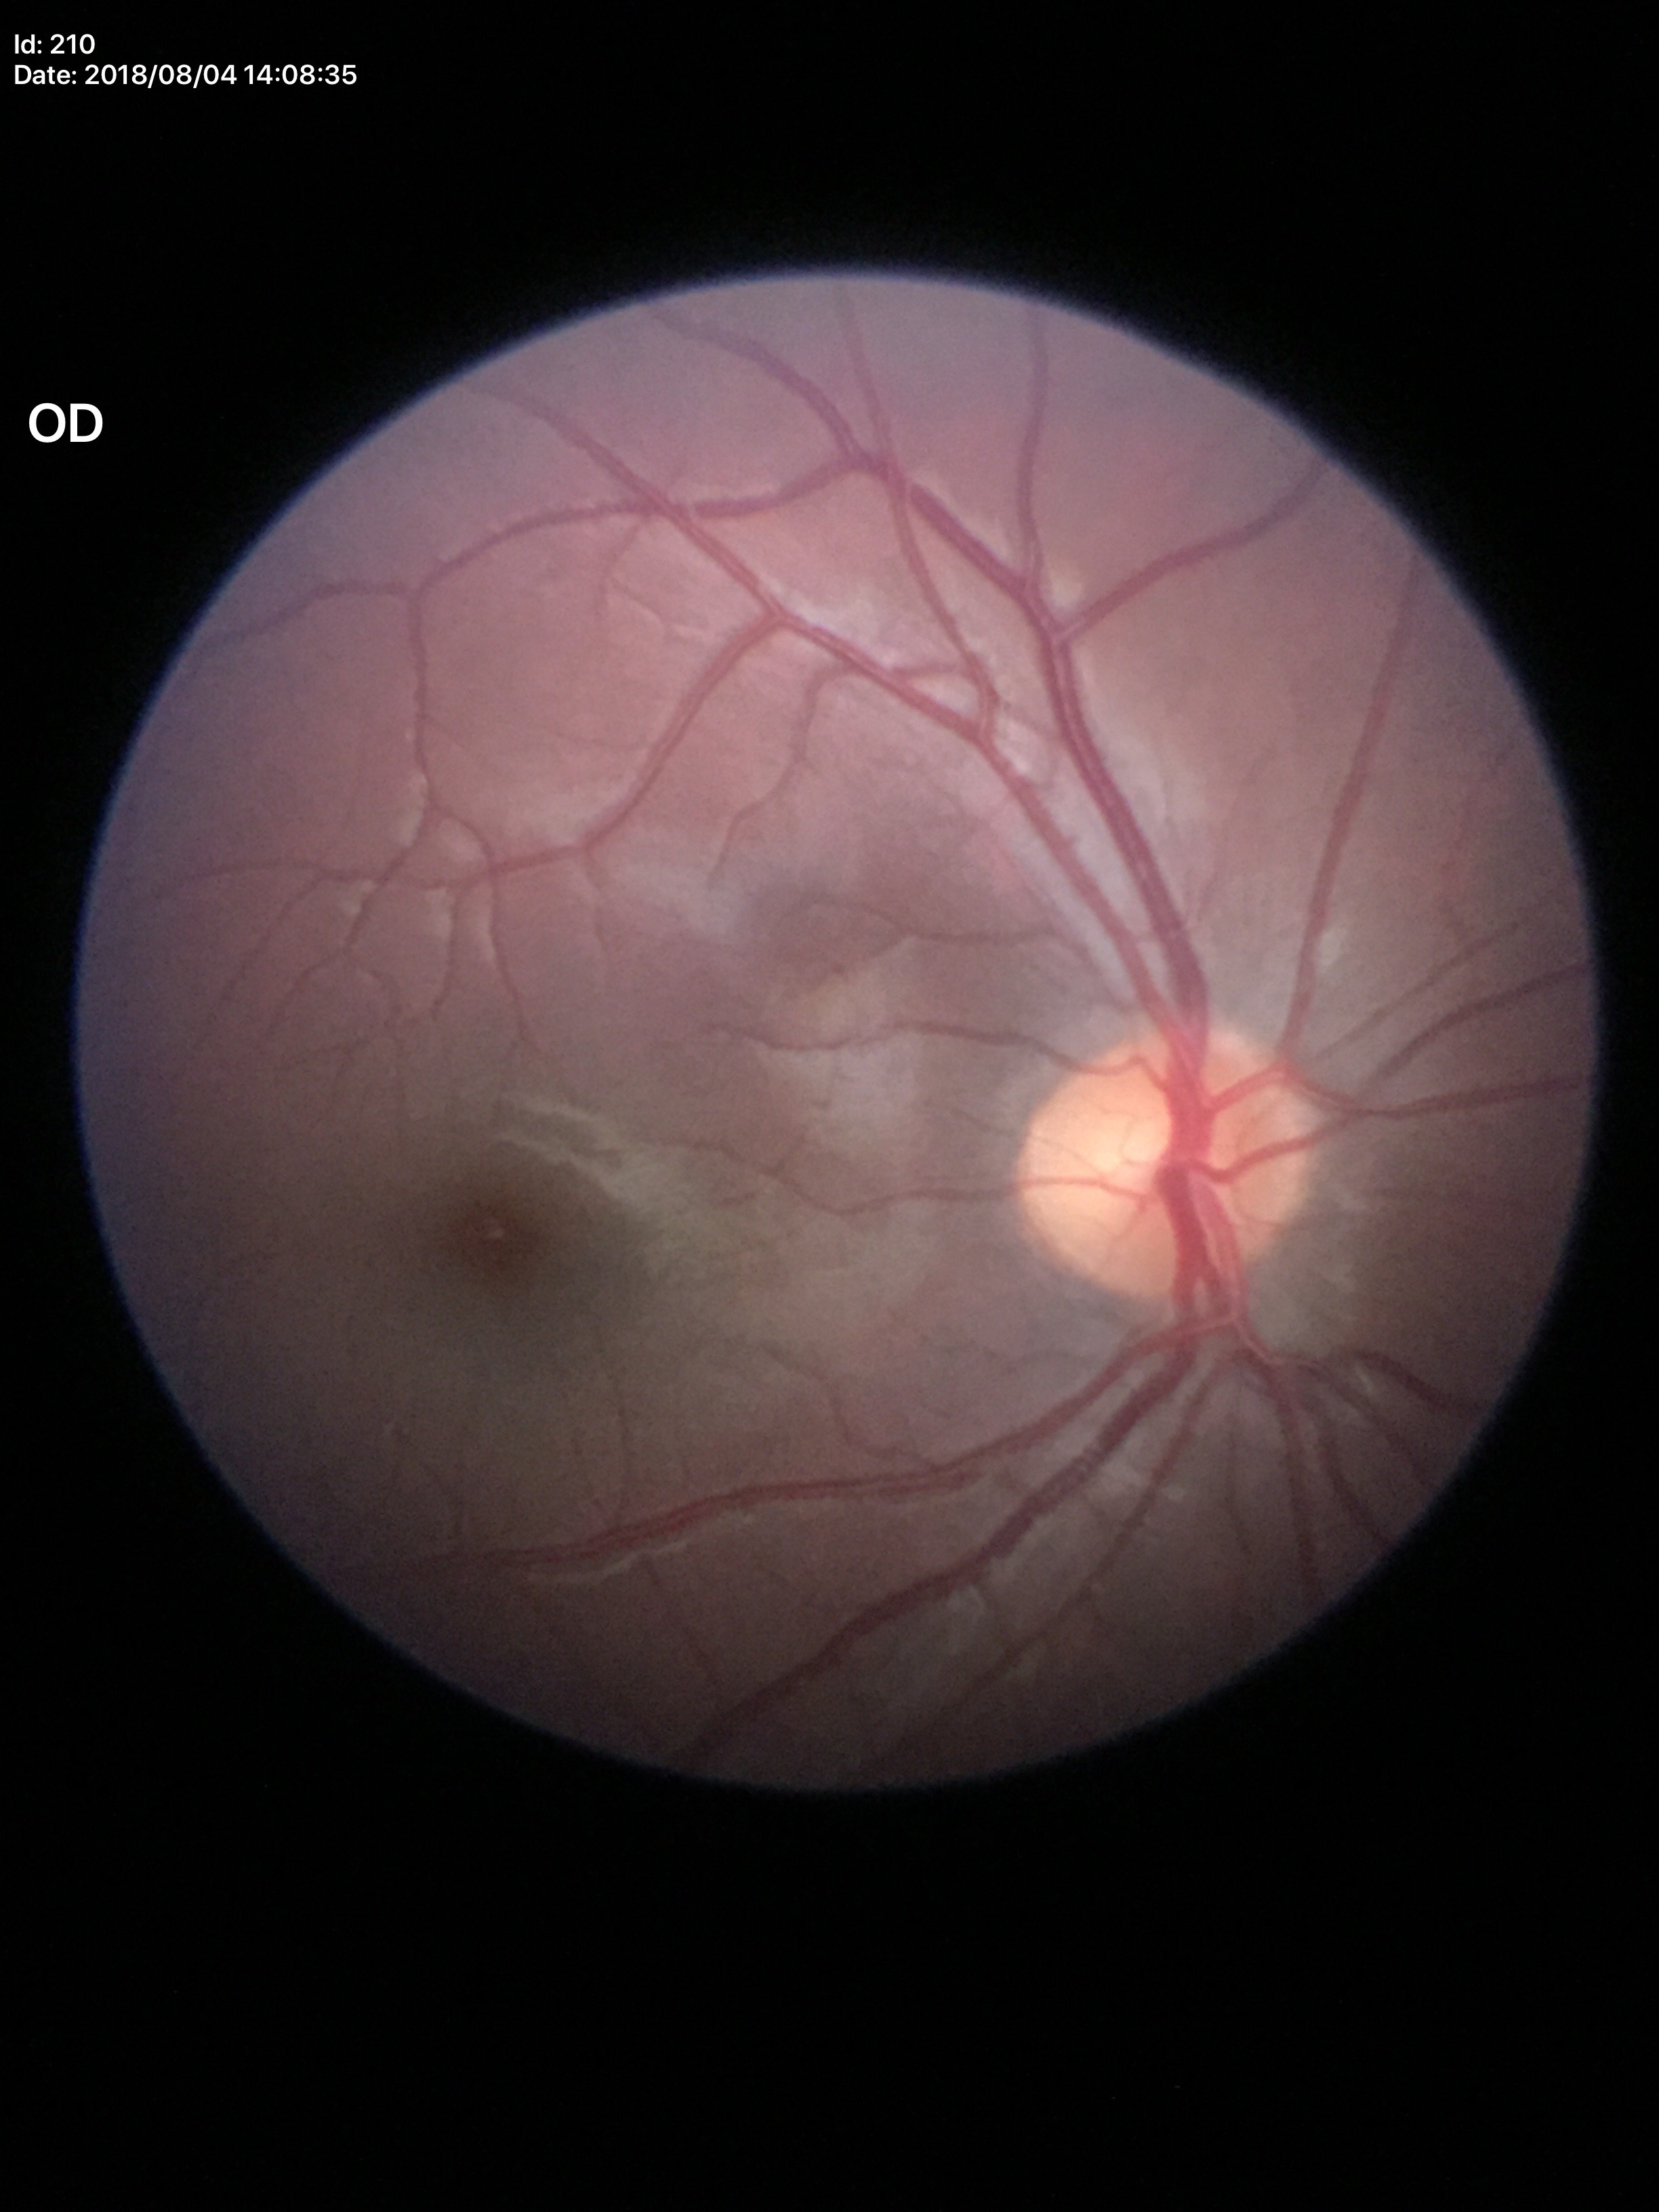

Glaucoma screening impression: negative.
VCDR: 0.51.
HCDR: 0.47.